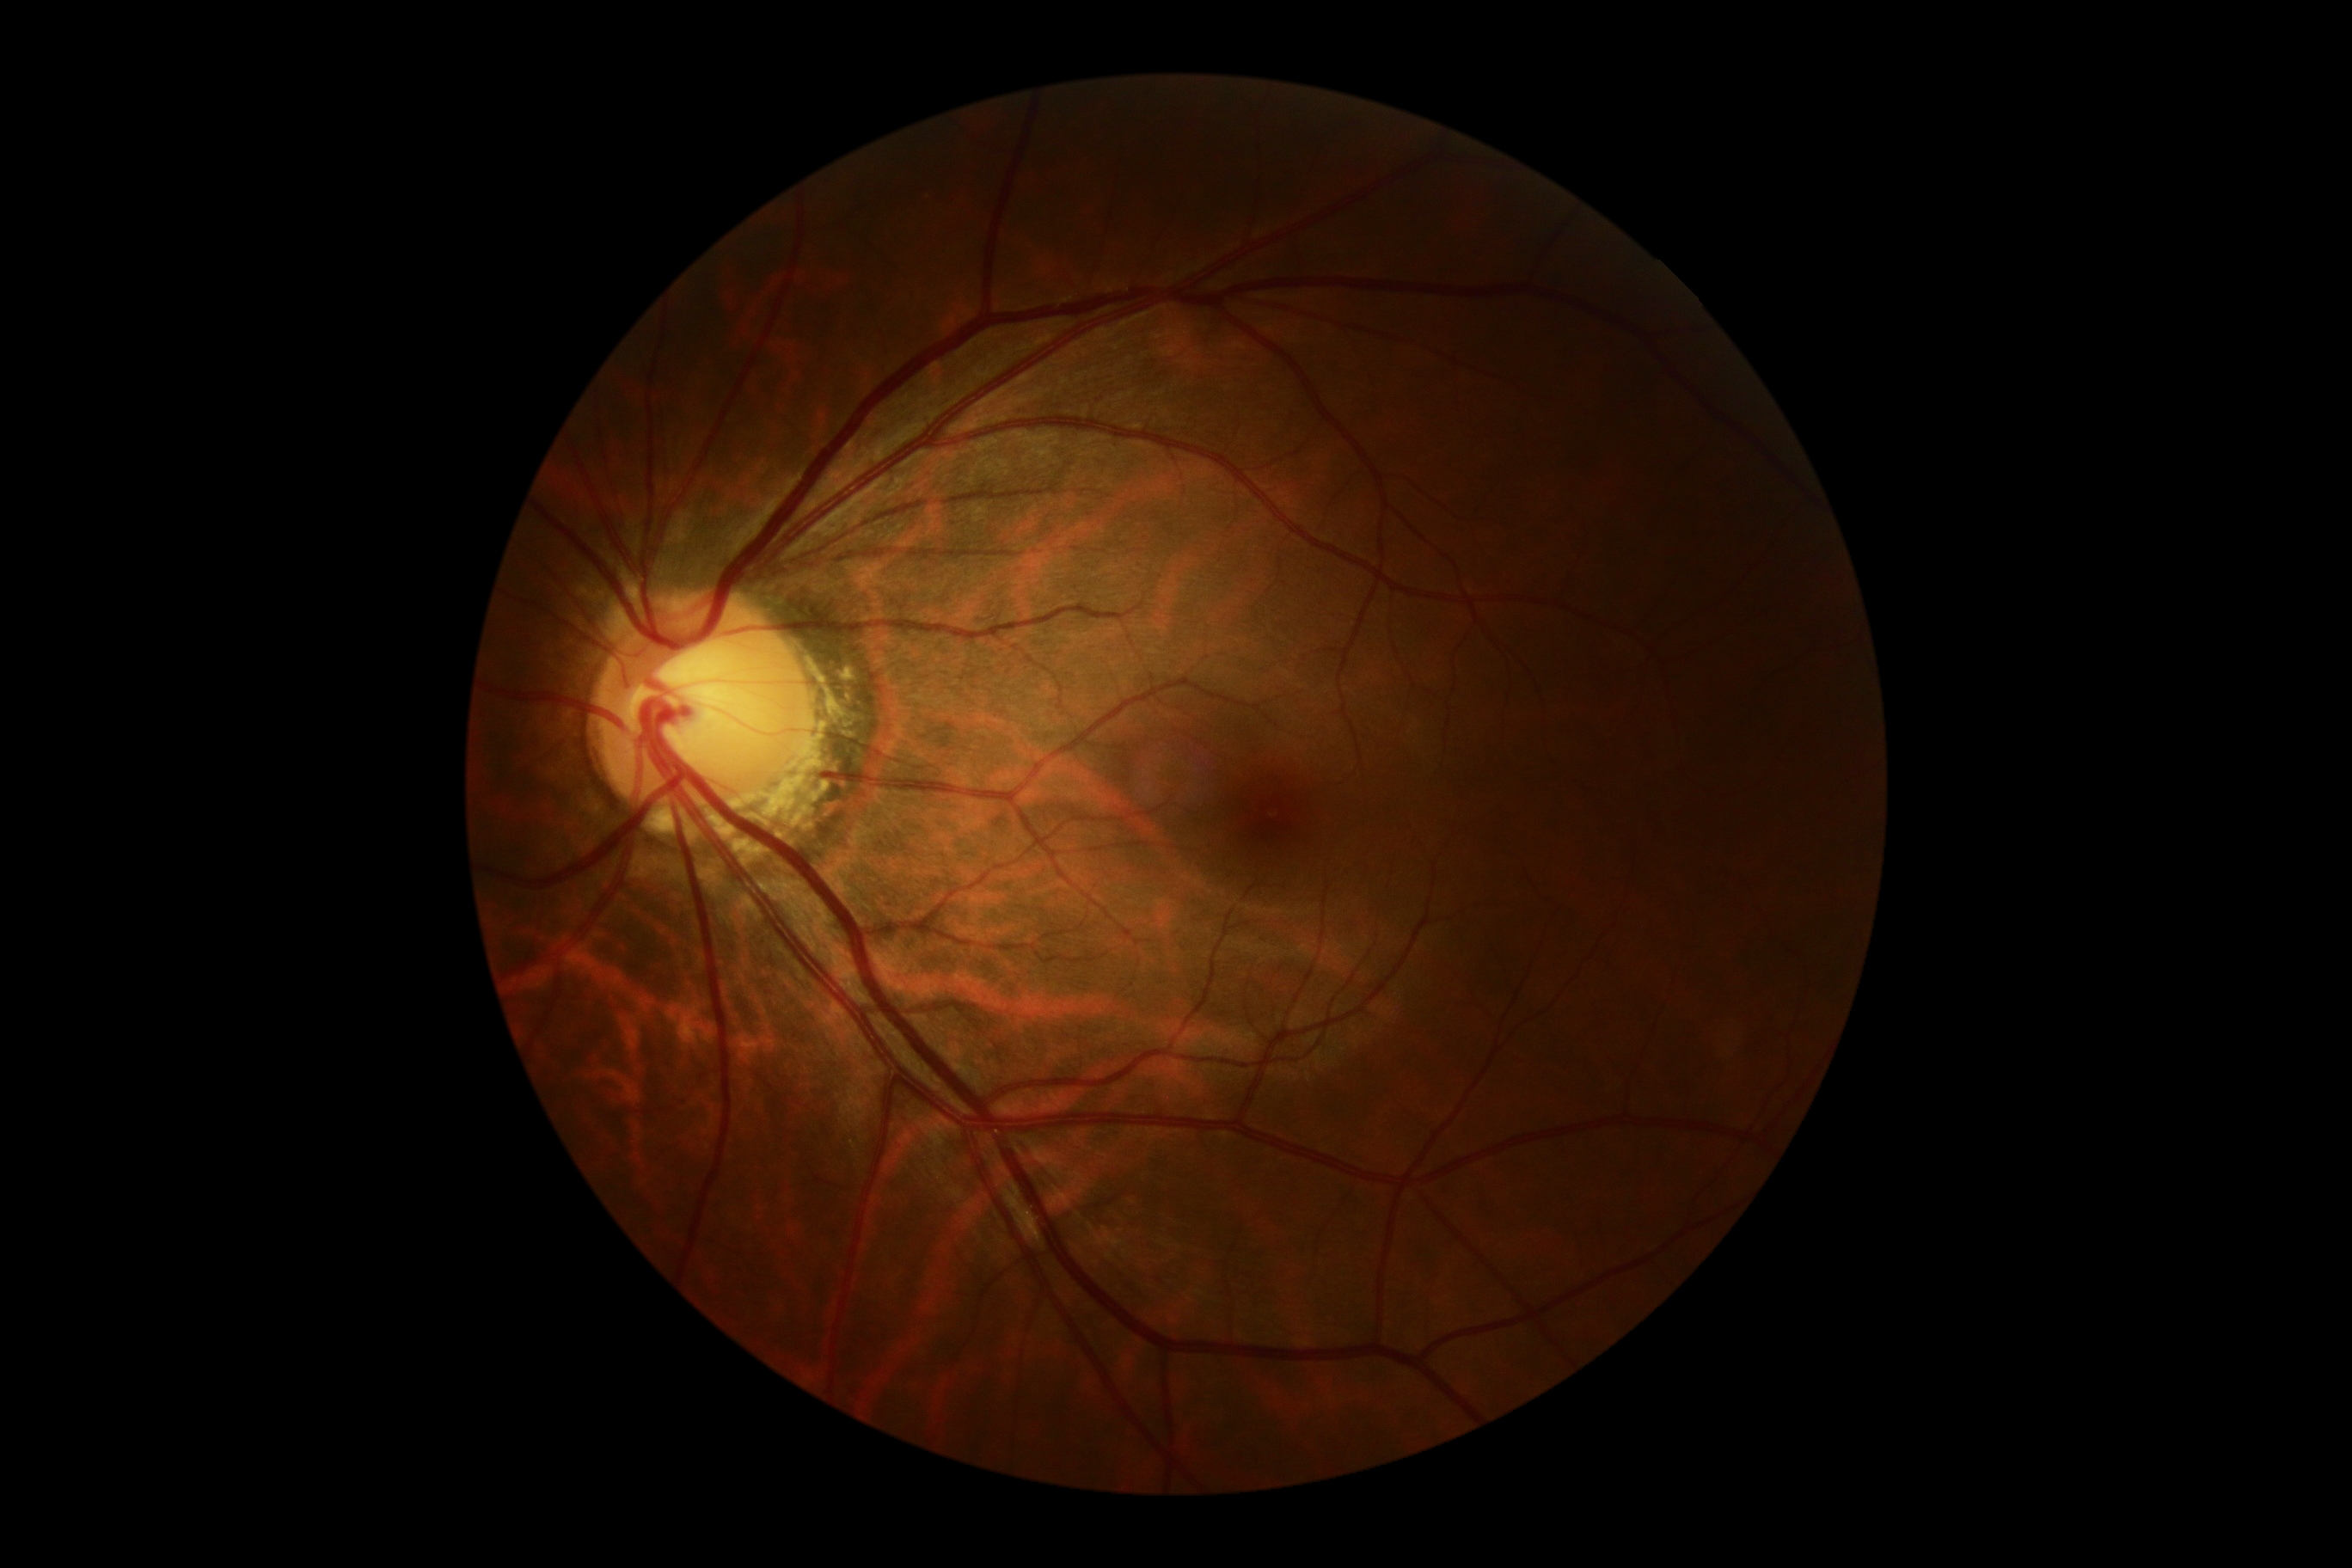 Diabetic retinopathy (DR): no apparent retinopathy (grade 0).
No diabetic retinal disease findings.